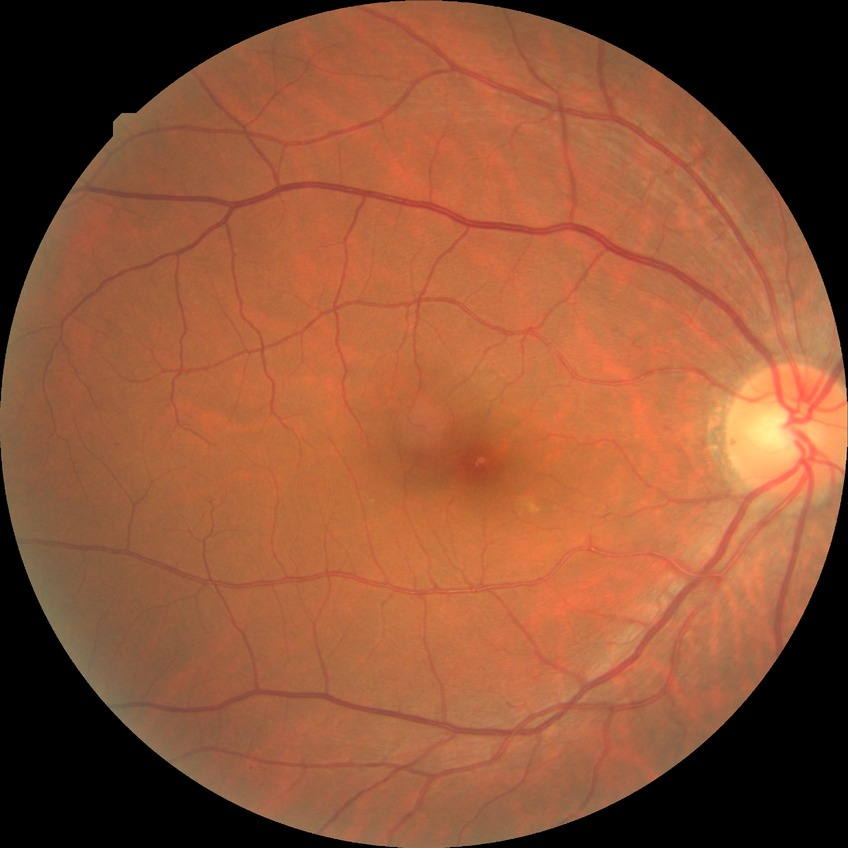 Diabetic retinopathy (DR): no diabetic retinopathy (NDR).